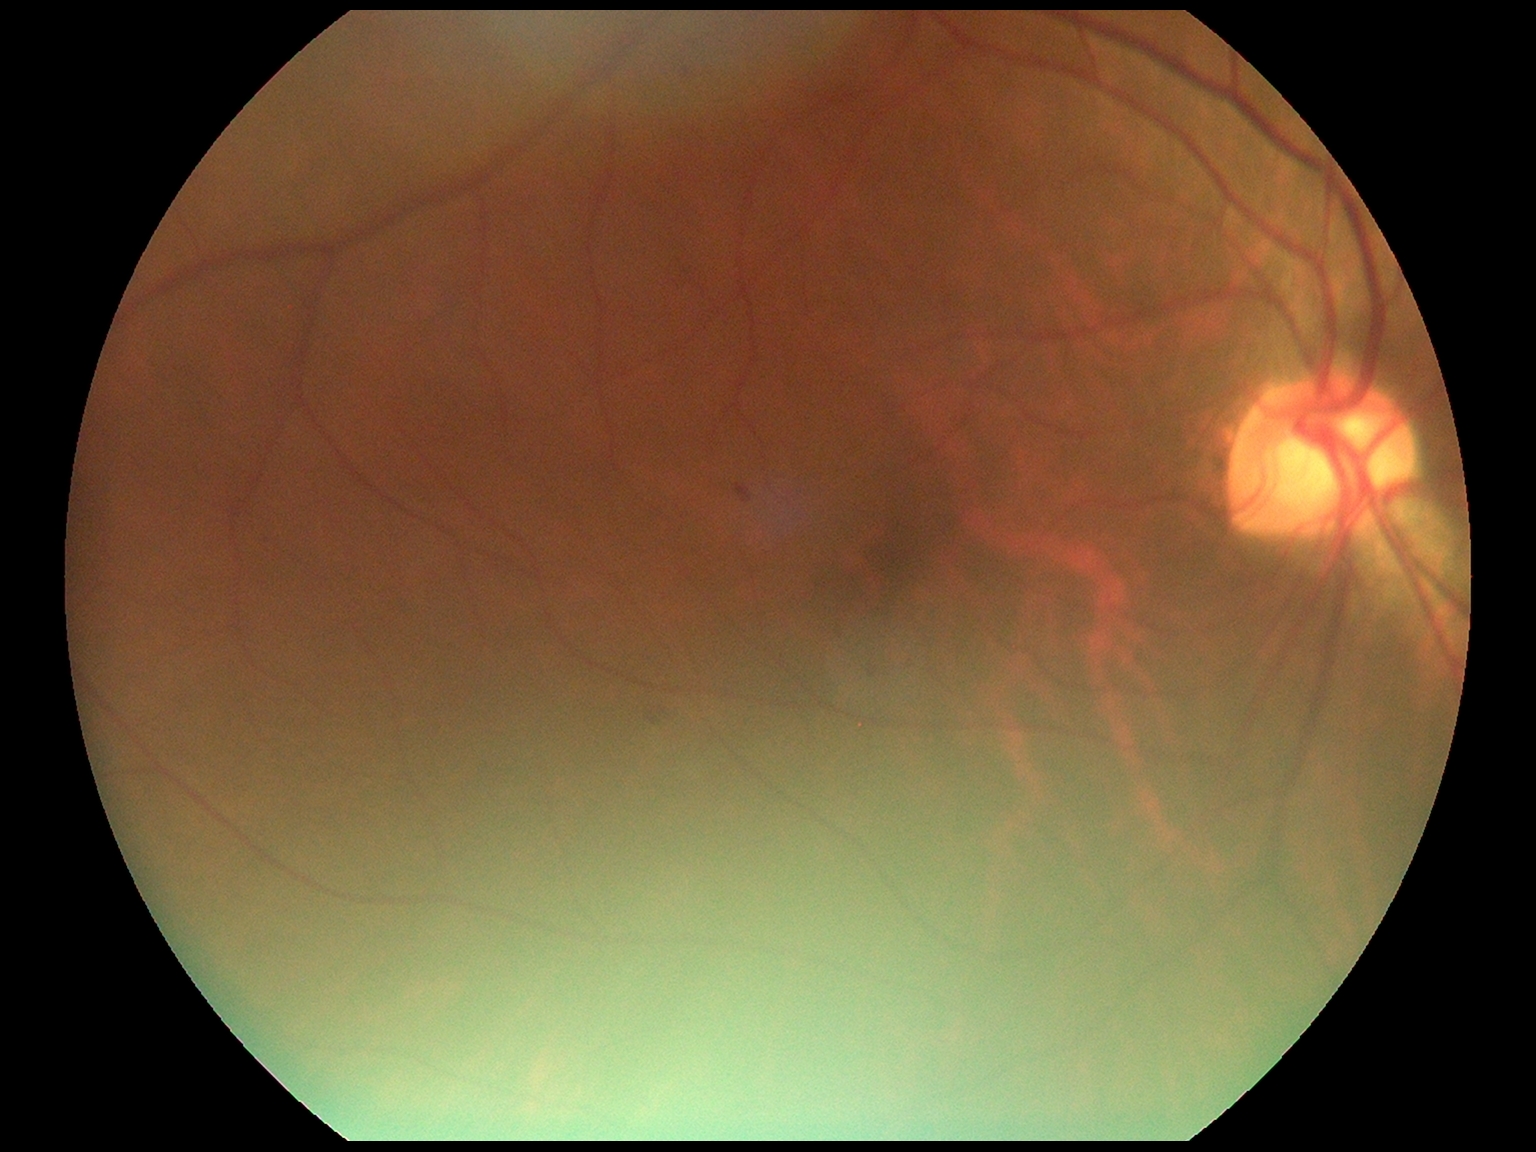

Retinopathy: moderate non-proliferative diabetic retinopathy (grade 2) — more than just microaneurysms but less than severe NPDR.